2102x1736px — 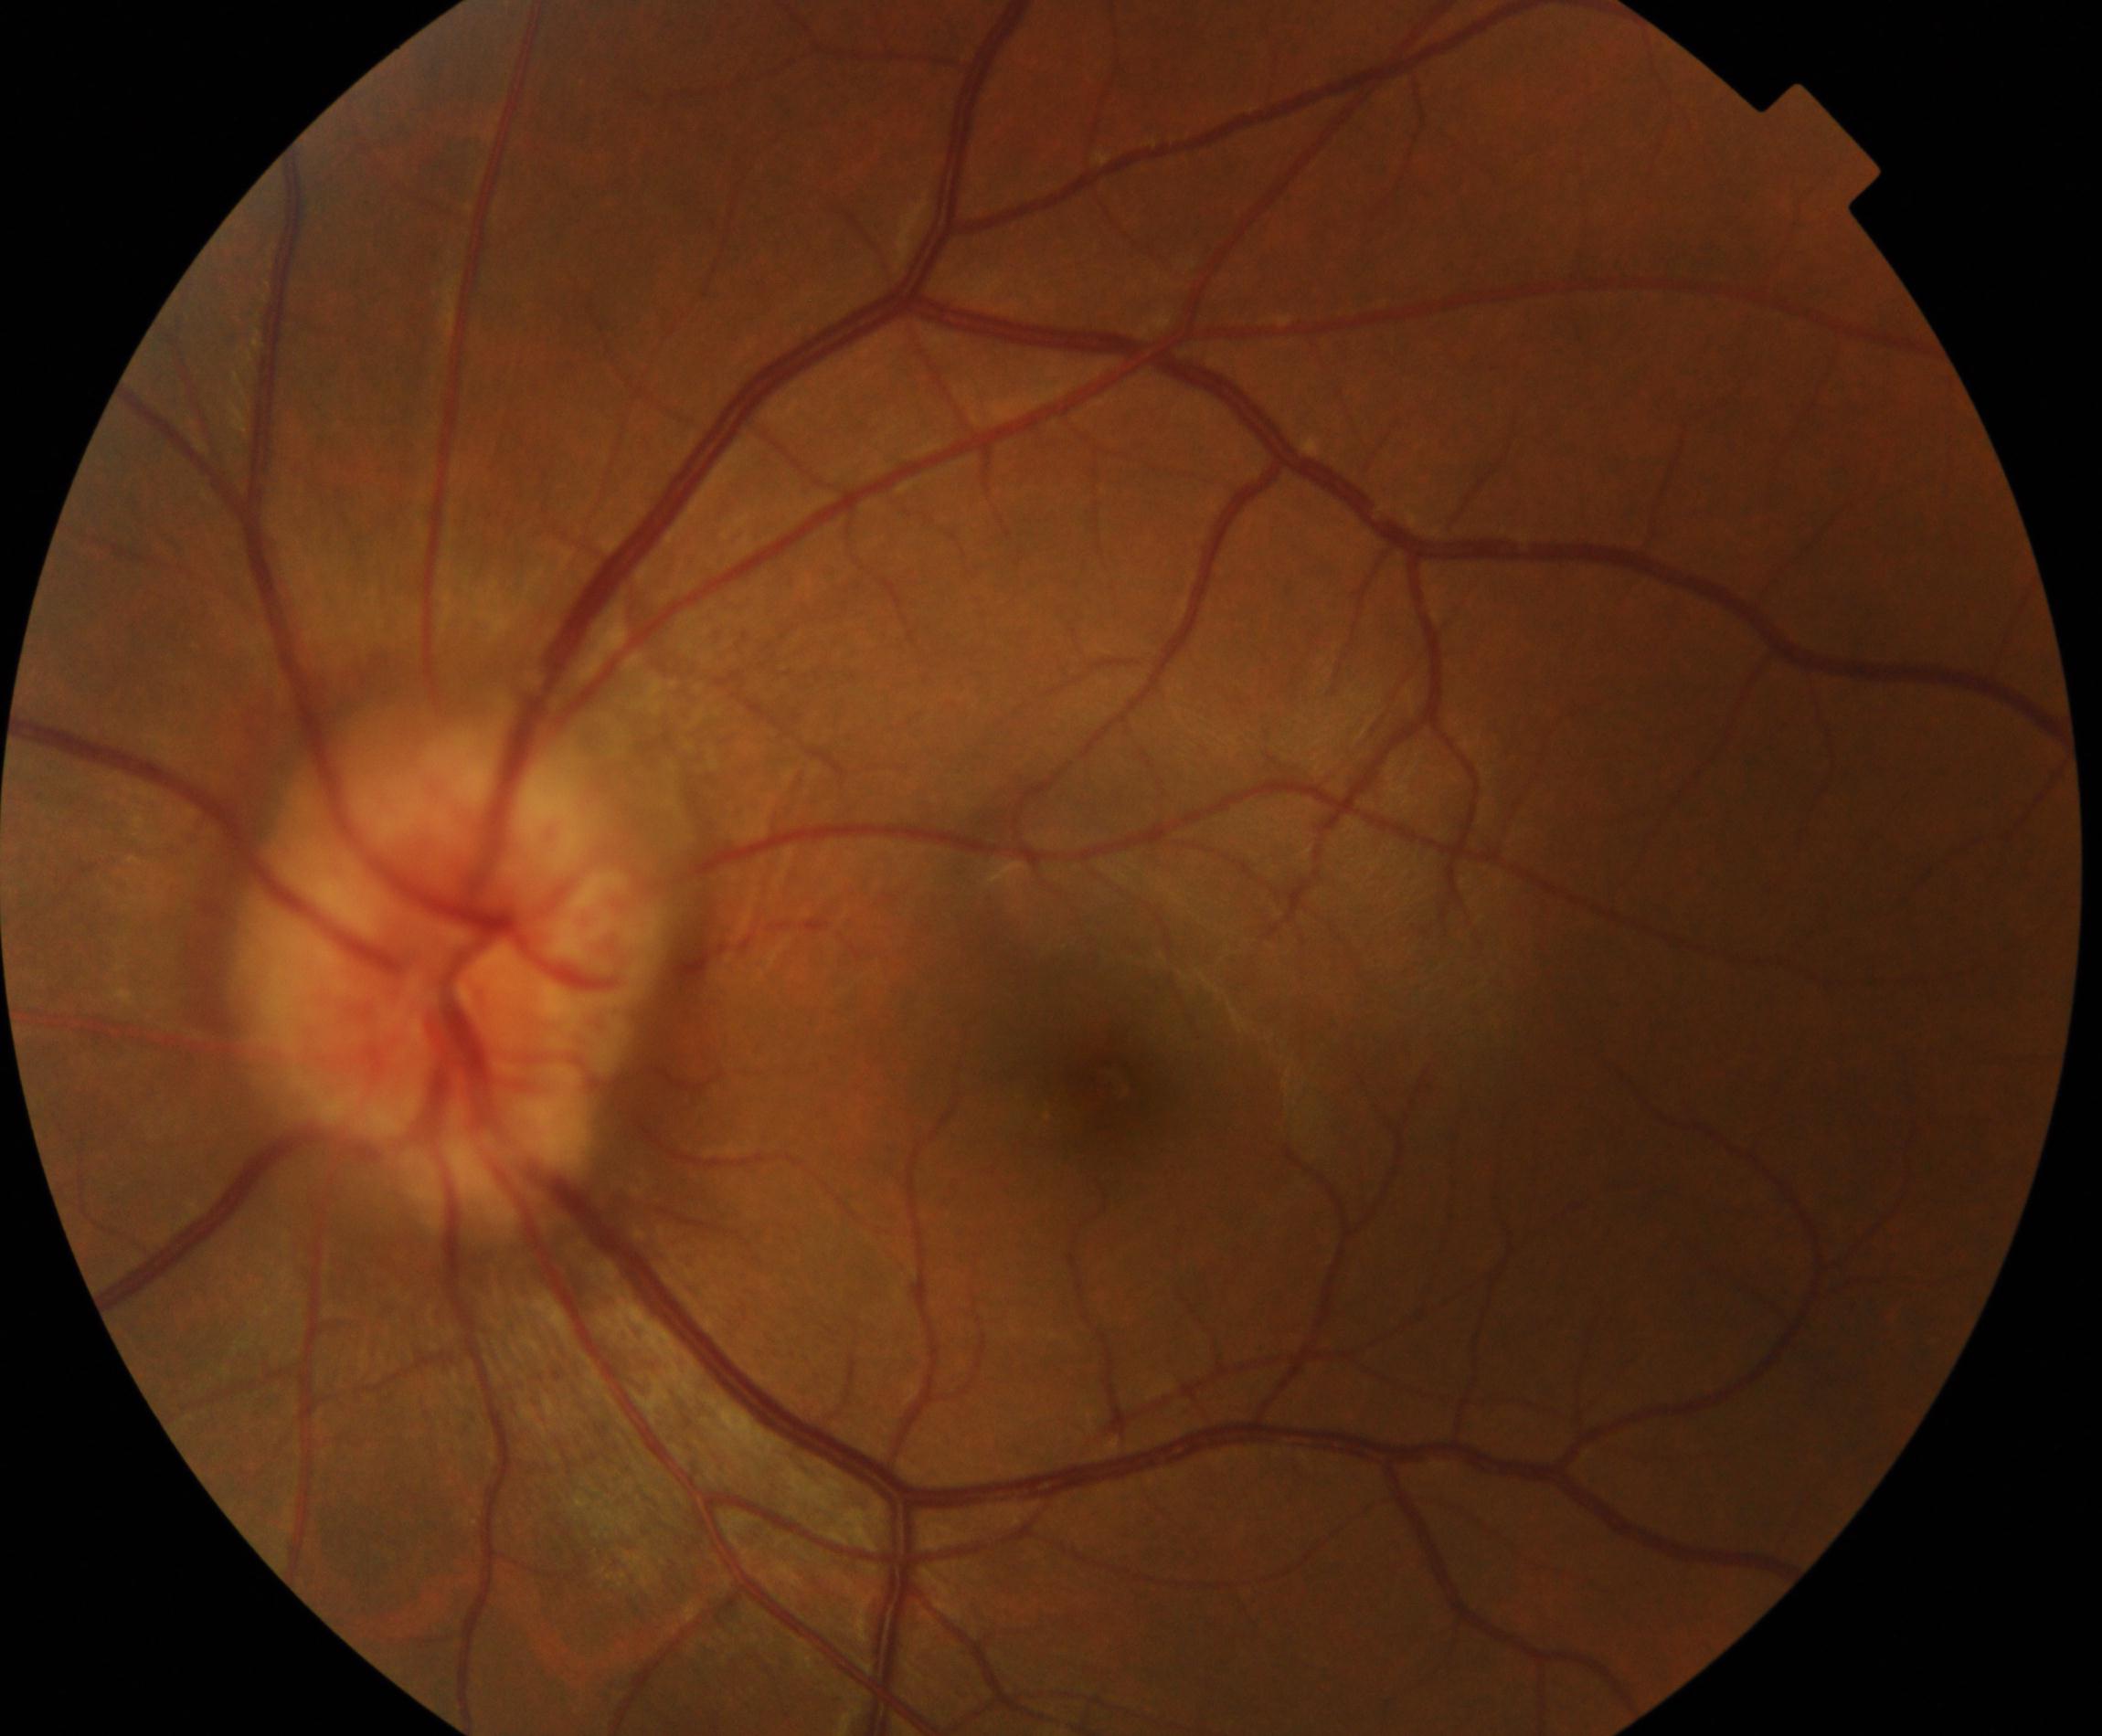
Classification: disc swelling and elevation. Typically showing disc hyperemia and elevation with indistinct disc margins, sometimes with peripapillary flame hemorrhages and cotton-wool spots.